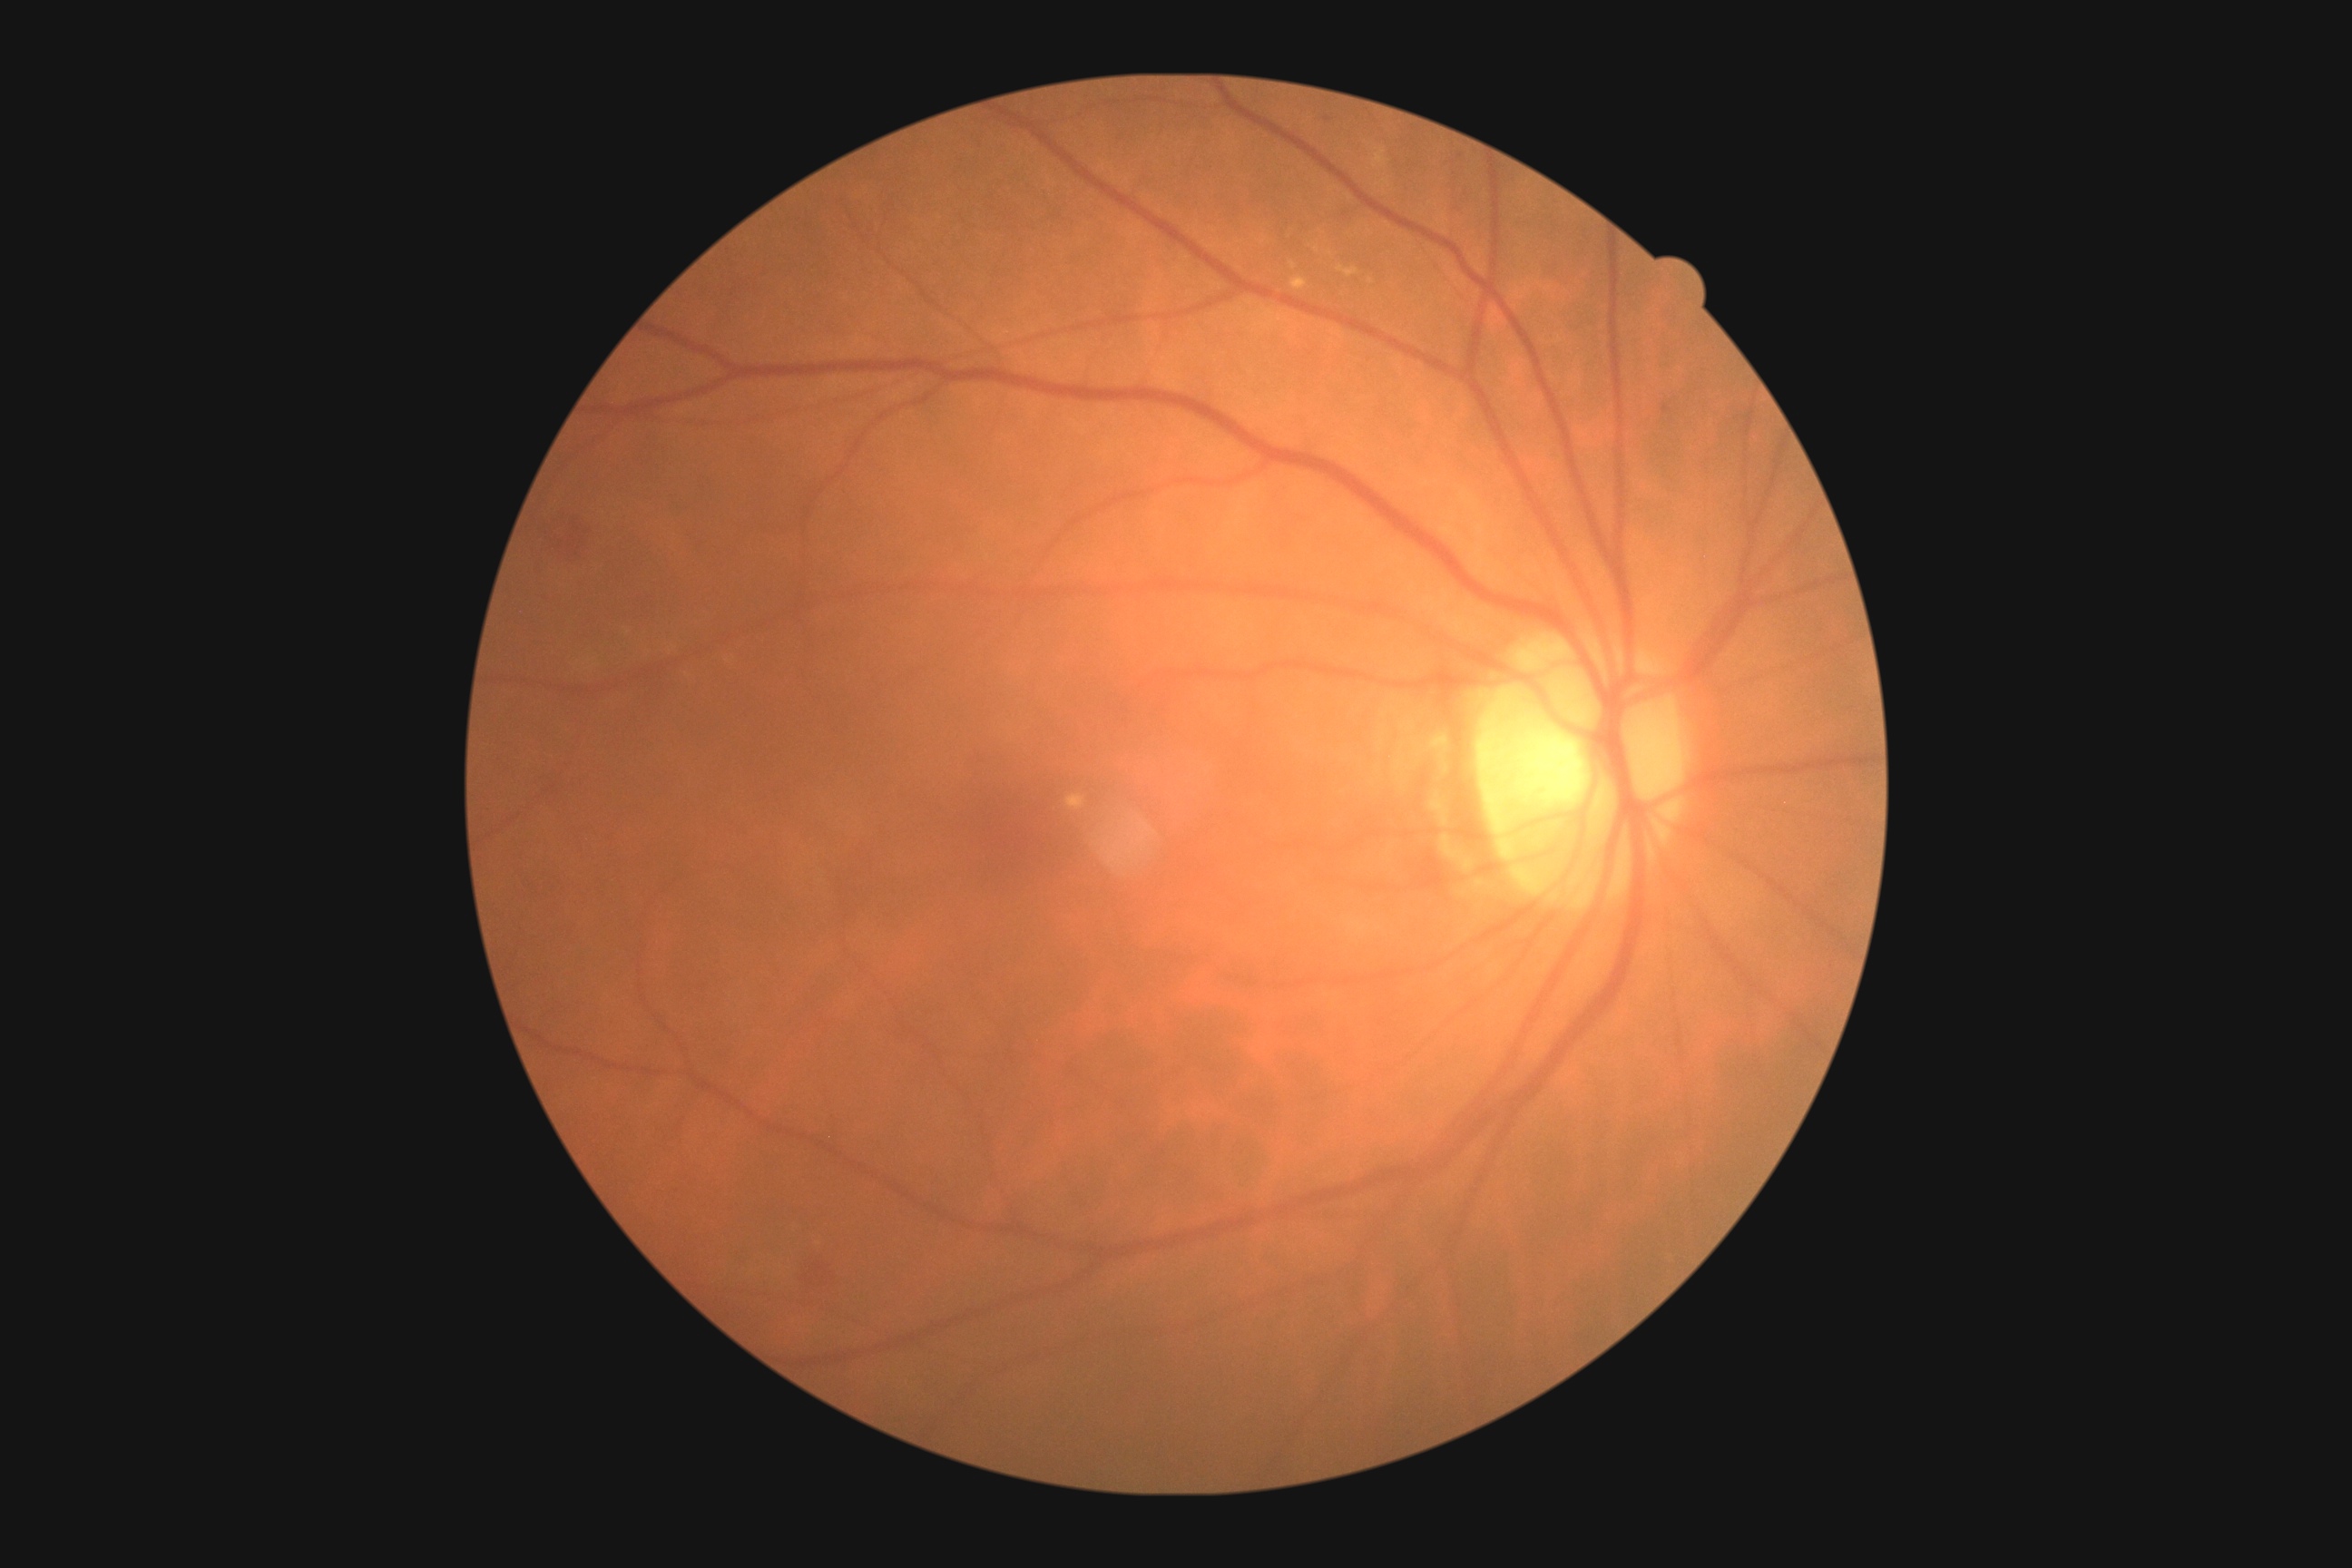   dr_grade: grade 2 (moderate NPDR) — more than just microaneurysms but less than severe NPDR